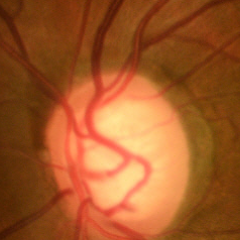

Glaucomatous changes are present. Glaucoma diagnosis = early glaucomatous changes.